130° field of view (Natus RetCam Envision). RetCam wide-field infant fundus image
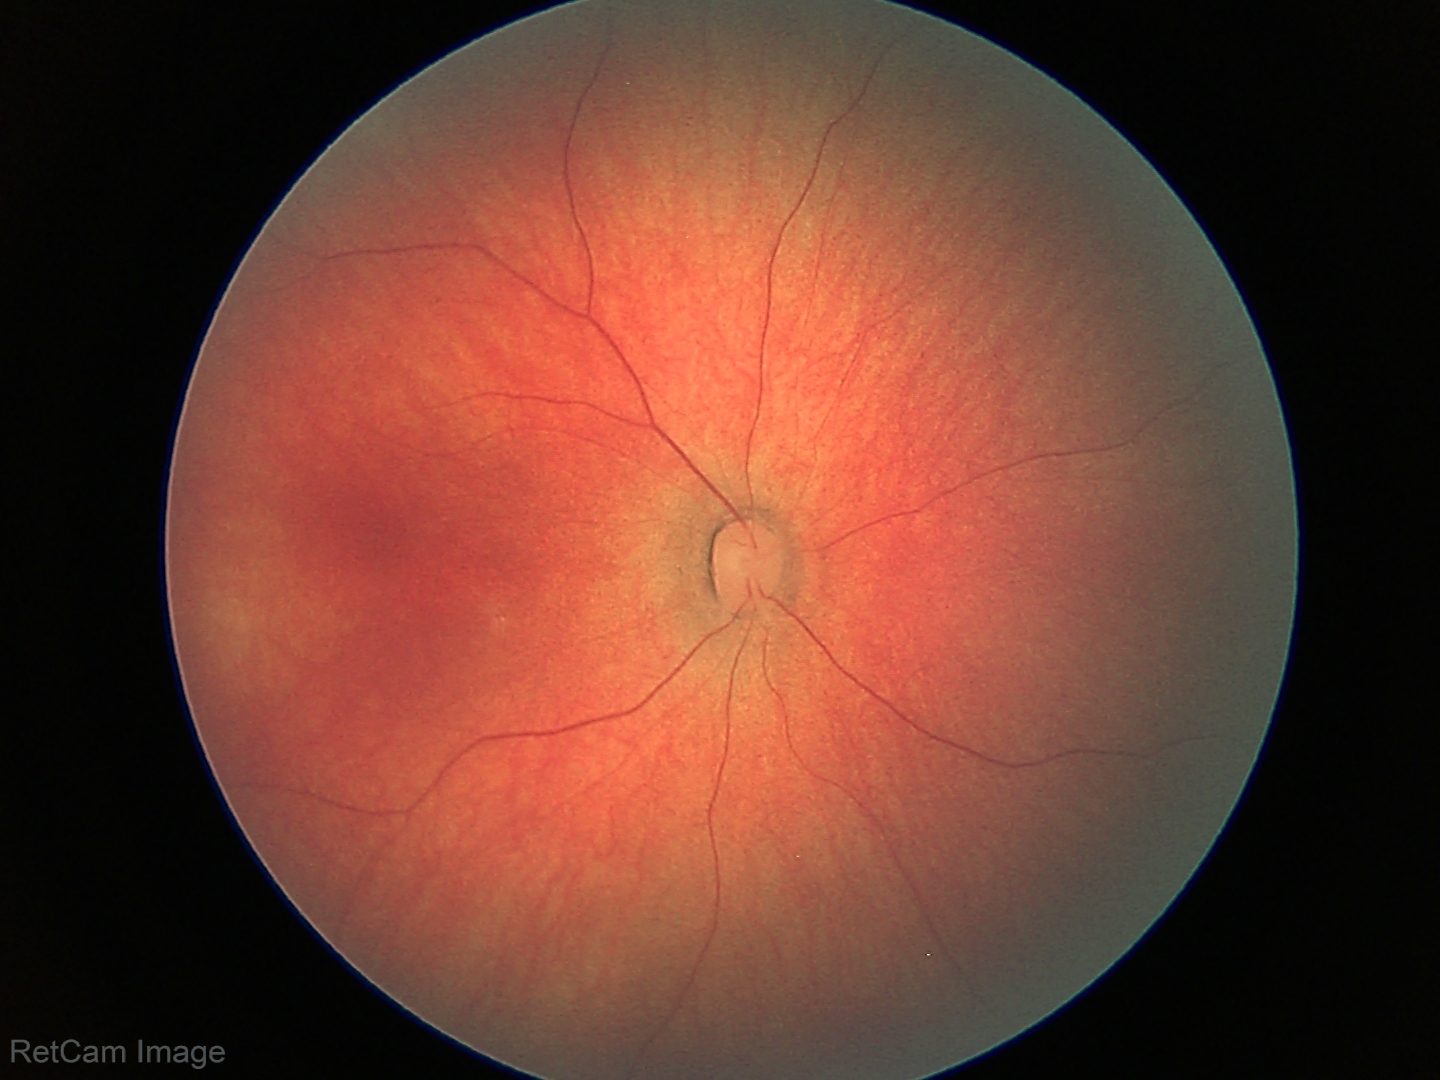

No retinal pathology identified on screening.